130° field of view (Natus RetCam Envision). Wide-field fundus image from infant ROP screening. Image size 1440x1080.
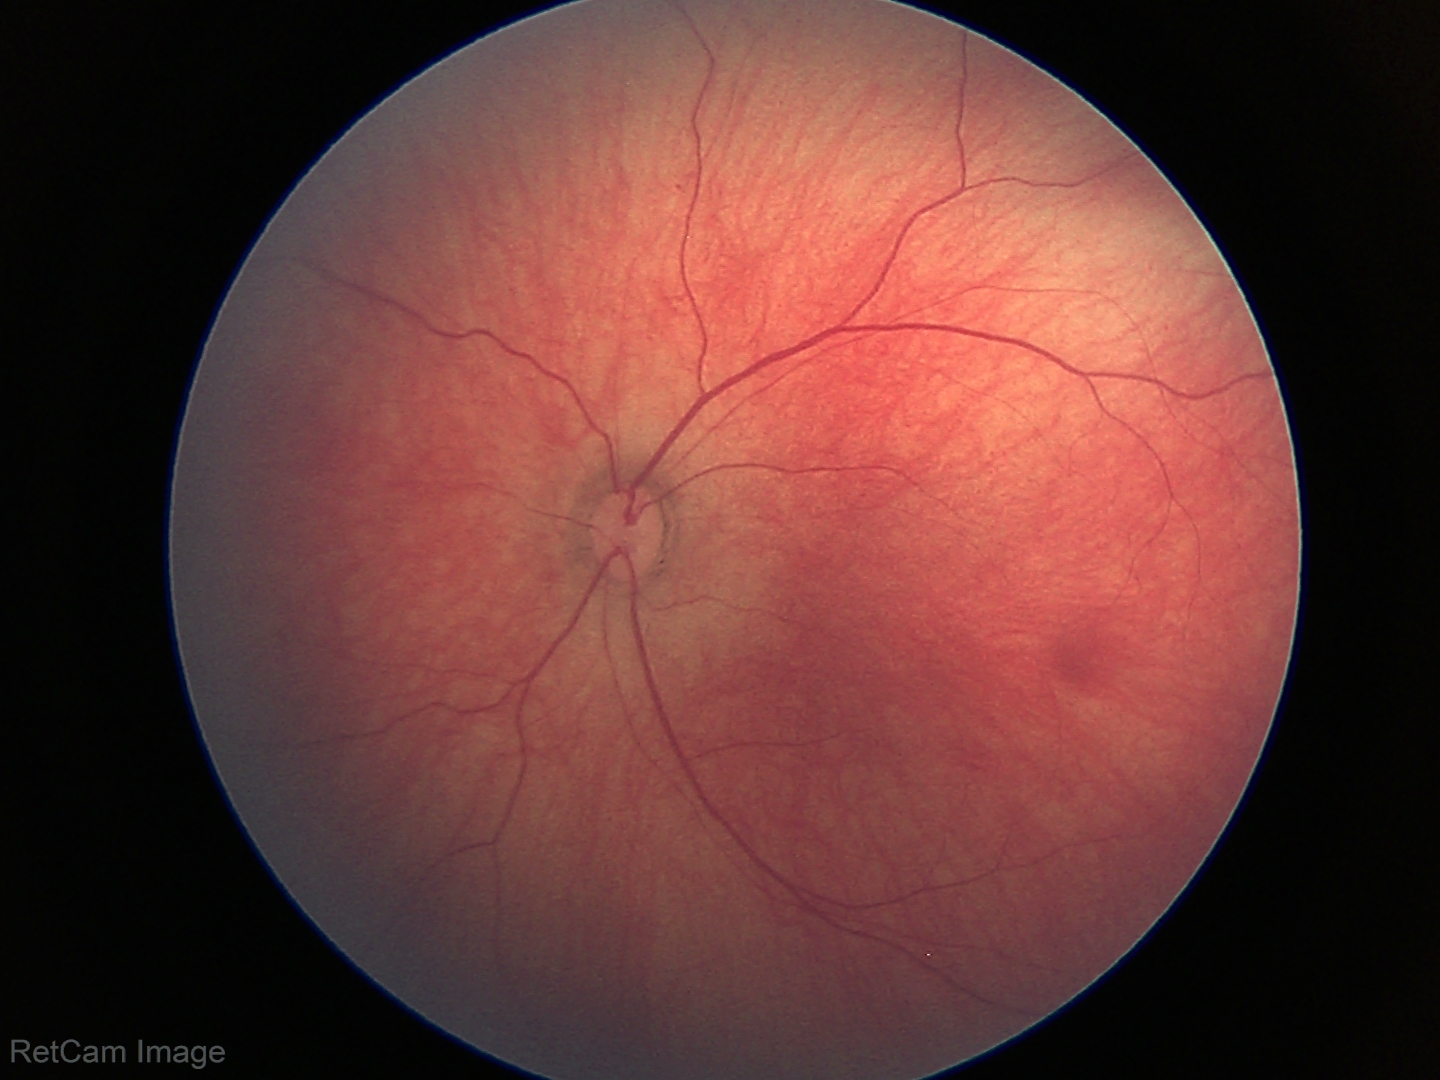 Screening examination with no abnormal retinal findings.